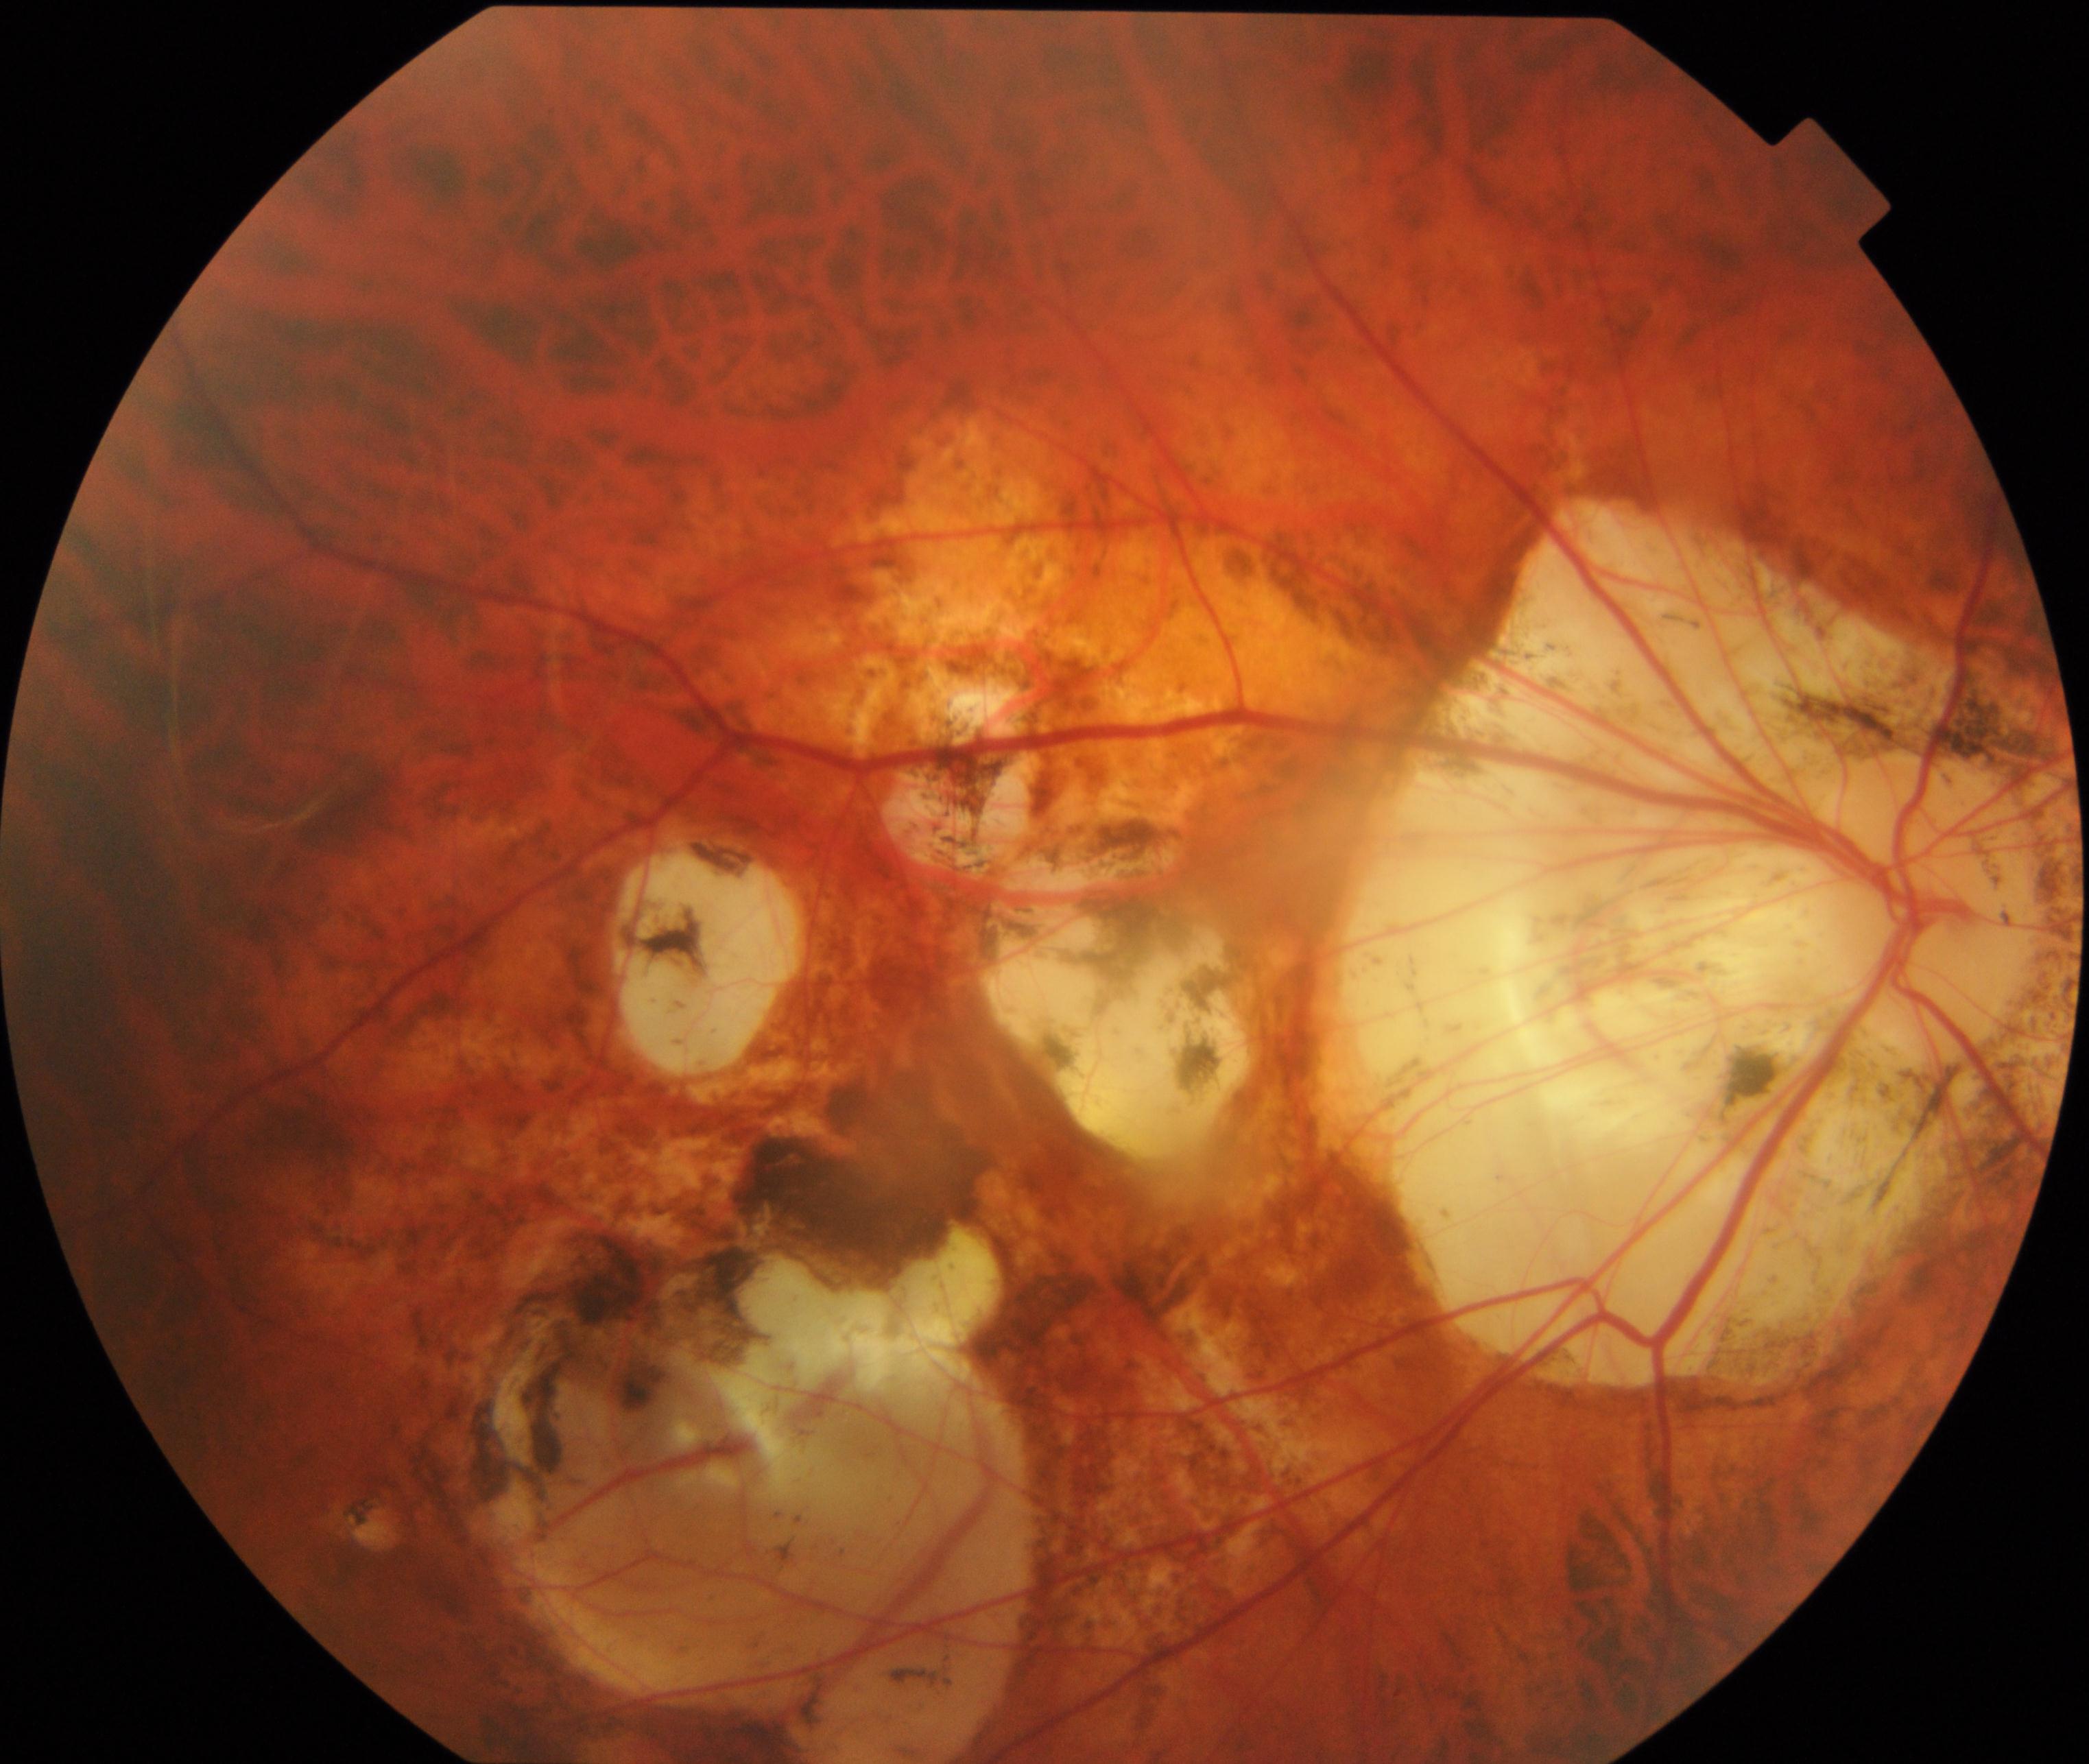 The image shows pathological myopia.